2361 by 1568 pixels.
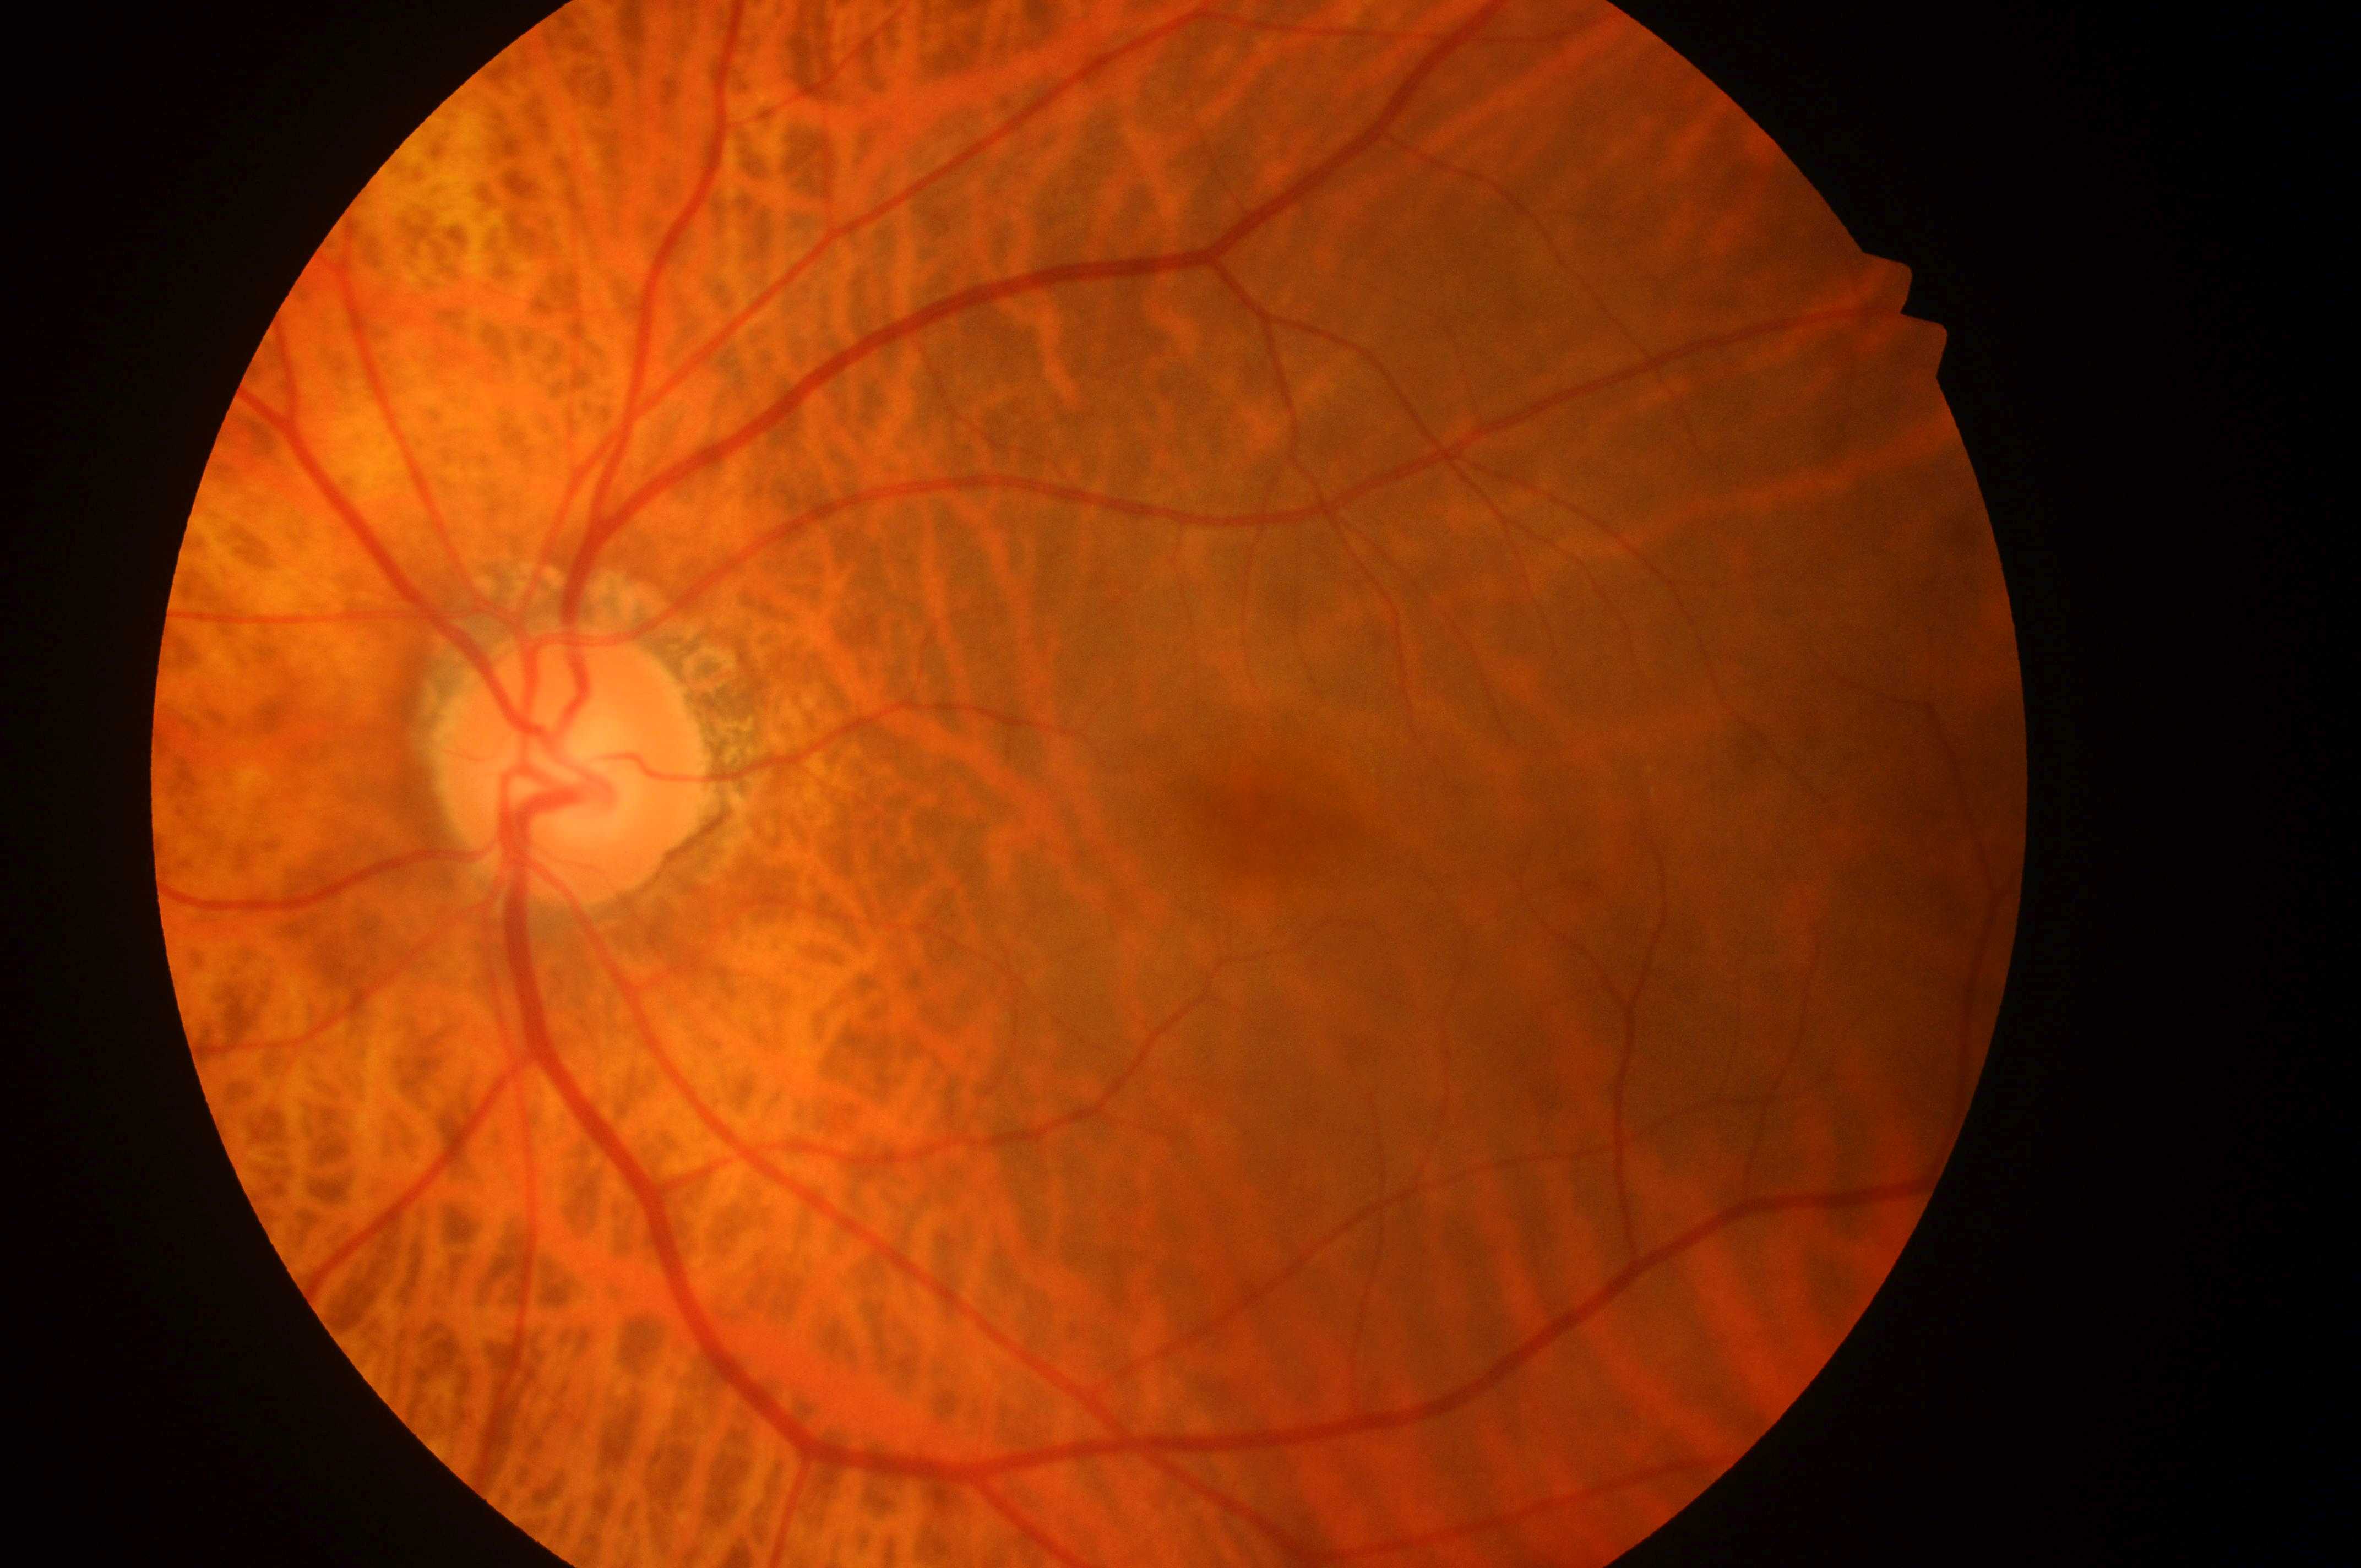 Diabetic retinopathy (DR) is 0.
Fovea centralis: 1271px, 829px.
Diabetic macular edema (DME) is grade 0.
Optic disk located at 563px, 775px.
Eye: OS.